Wide-field contact fundus photograph of an infant
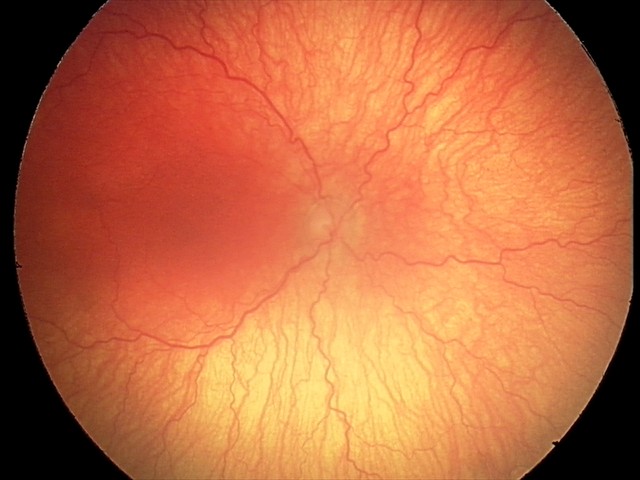

Plus disease = present — abnormal dilation and tortuosity of the posterior pole retinal vessels
finding = A-ROP (aggressive ROP)